Bosch fundus camera. 1920 x 1440 pixels: 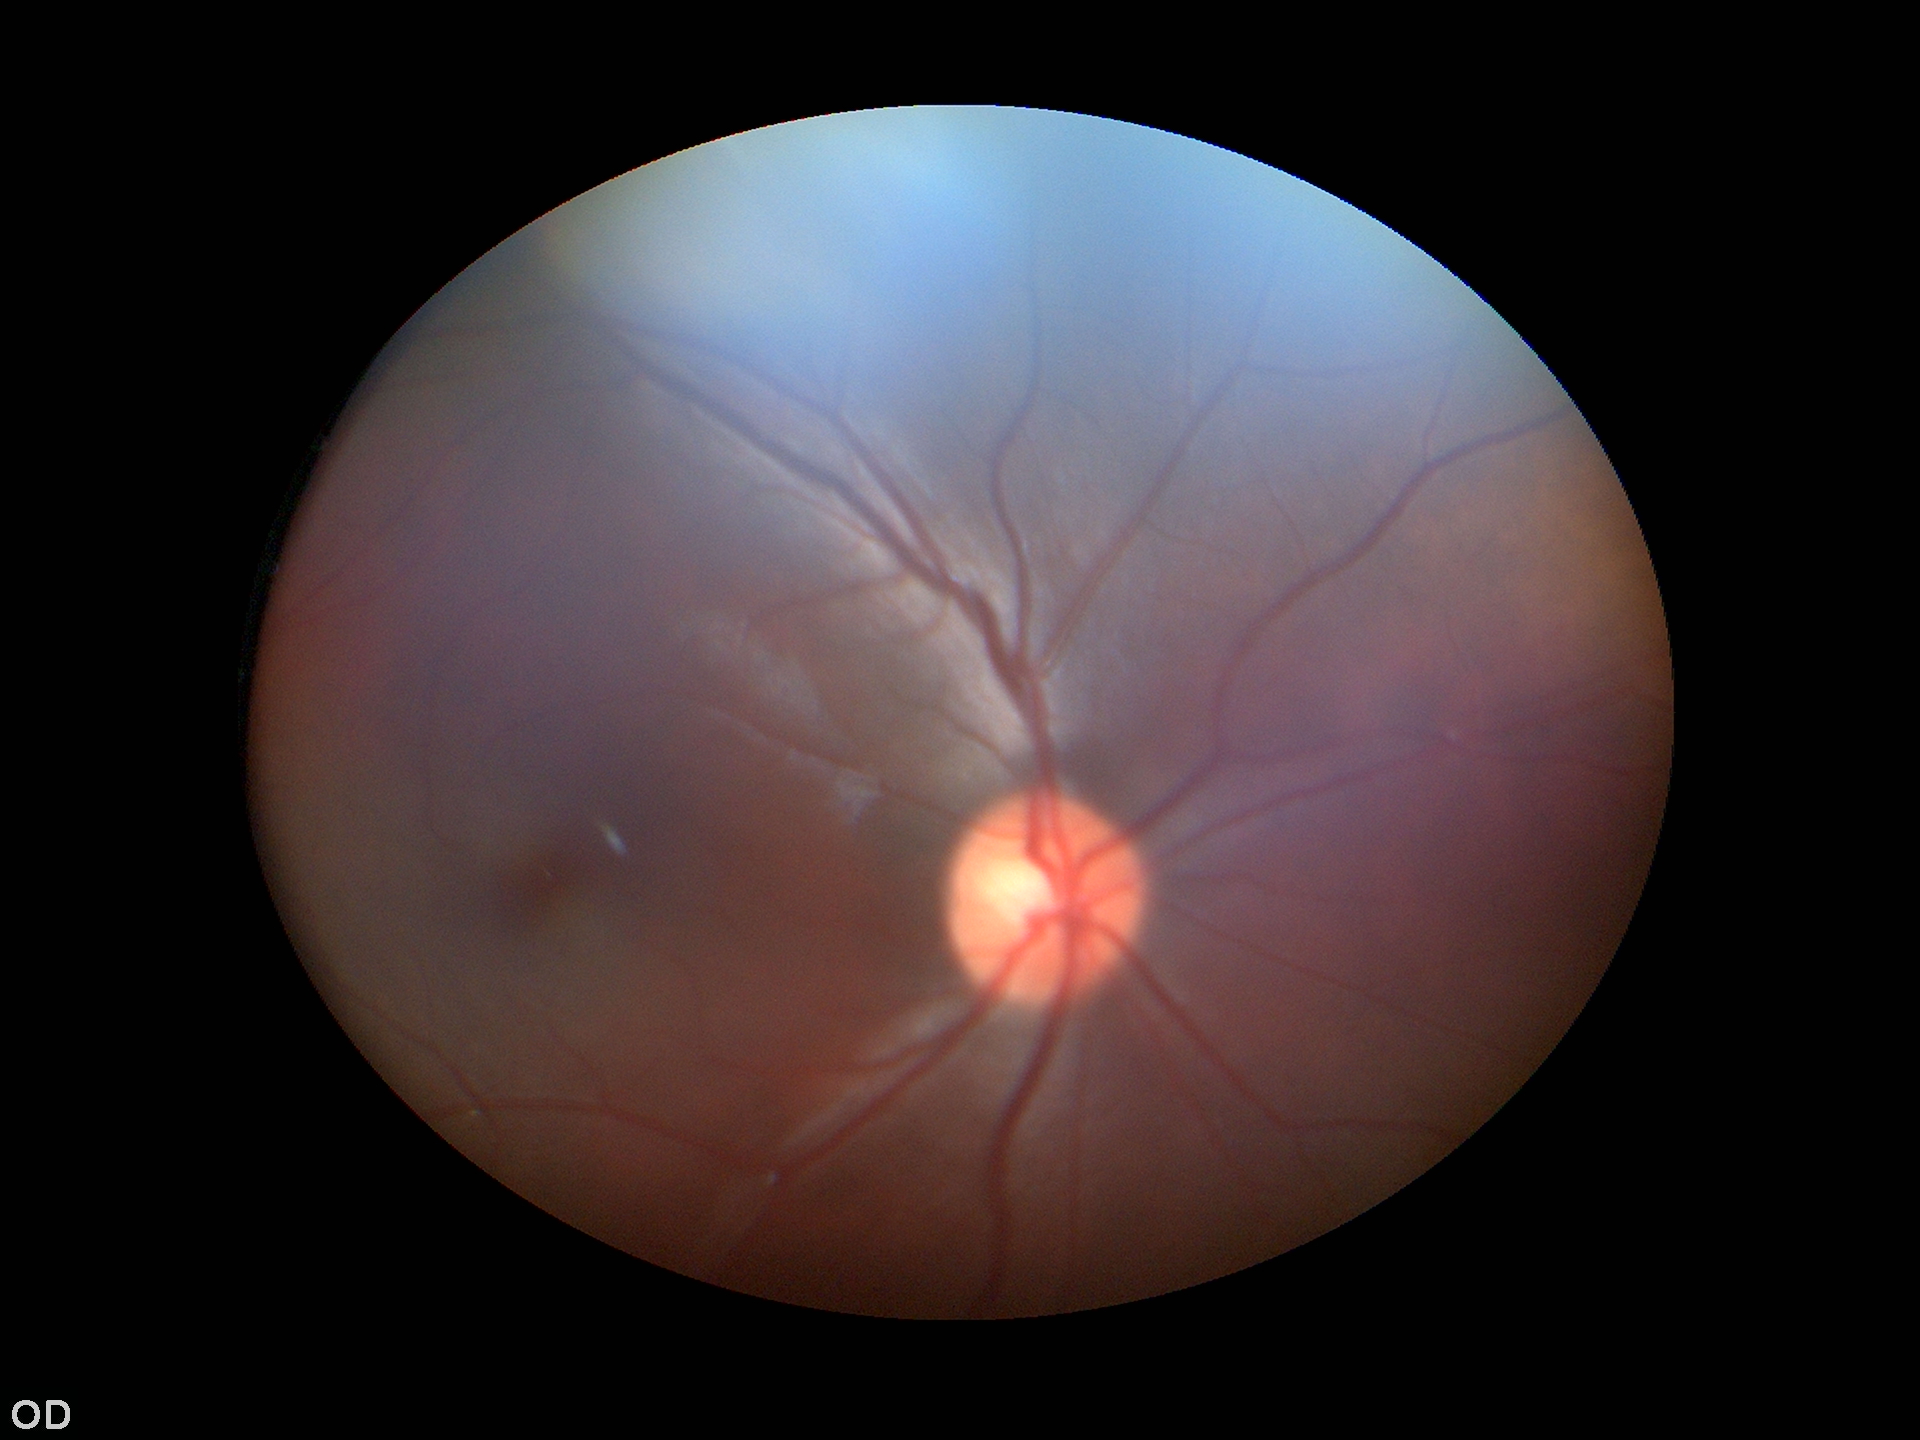 Glaucoma screening: no suspicious findings.
Vertical C/D ratio of 0.48.
Area cup-disc ratio: 0.24.
Horizontal C/D ratio: 0.47.